CFP:
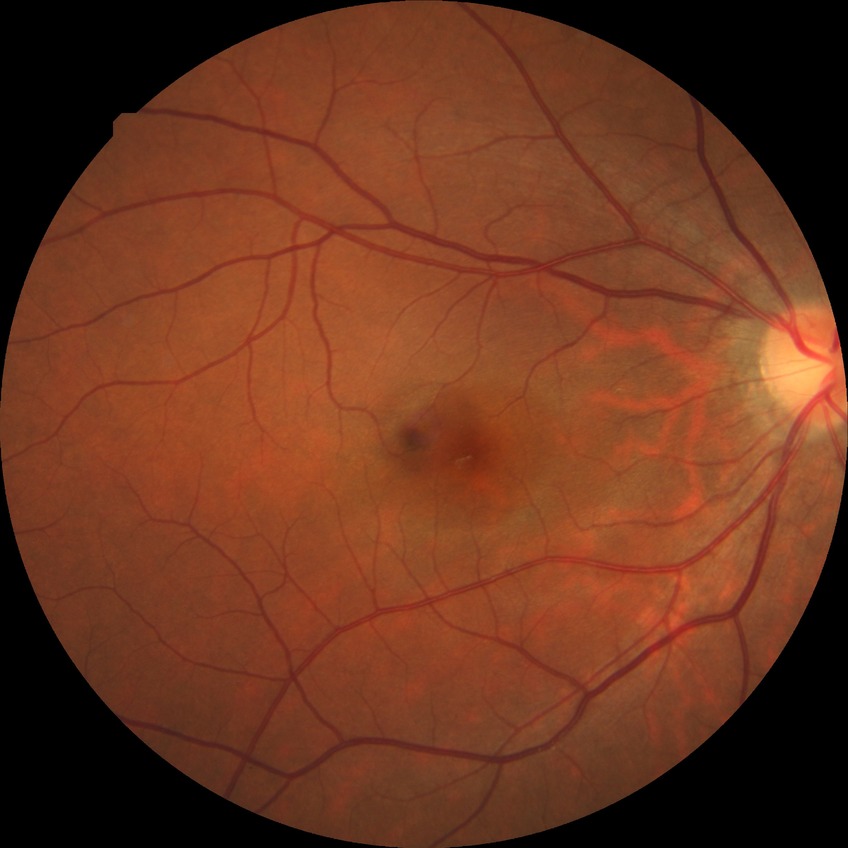

Annotations:
* retinopathy grade: no diabetic retinopathy